Retinal fundus photograph. NIDEK AFC-230 fundus camera: 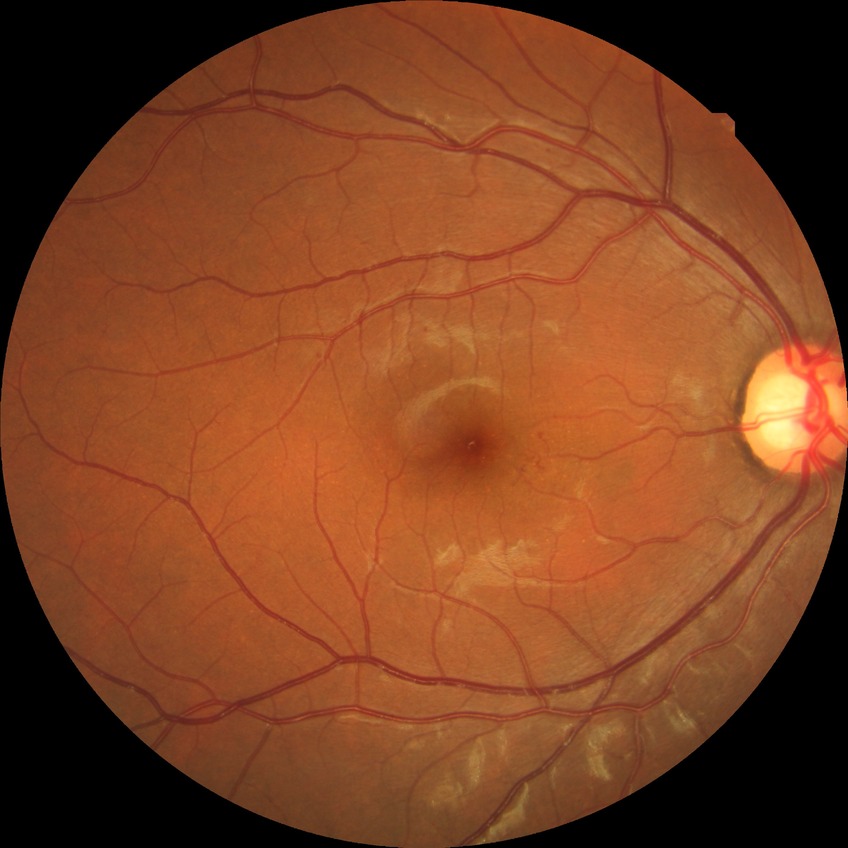 Disease class: non-proliferative diabetic retinopathy.
Diabetic retinopathy (DR): SDR (simple diabetic retinopathy).